Captured with the Clarity RetCam 3 (130° field of view). Wide-field contact fundus photograph of an infant.
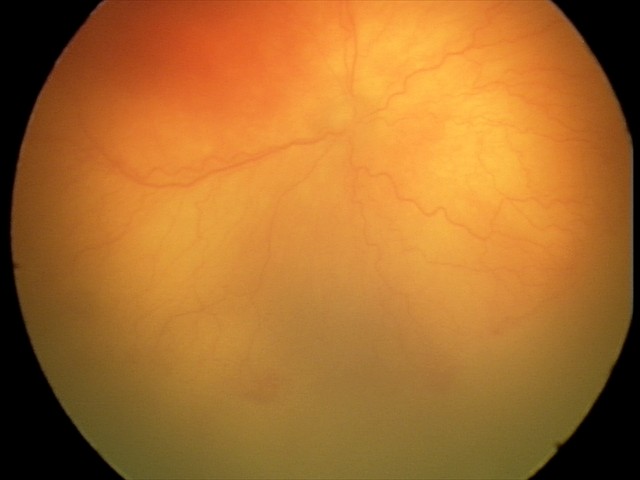

Screening: aggressive retinopathy of prematurity | plus disease.